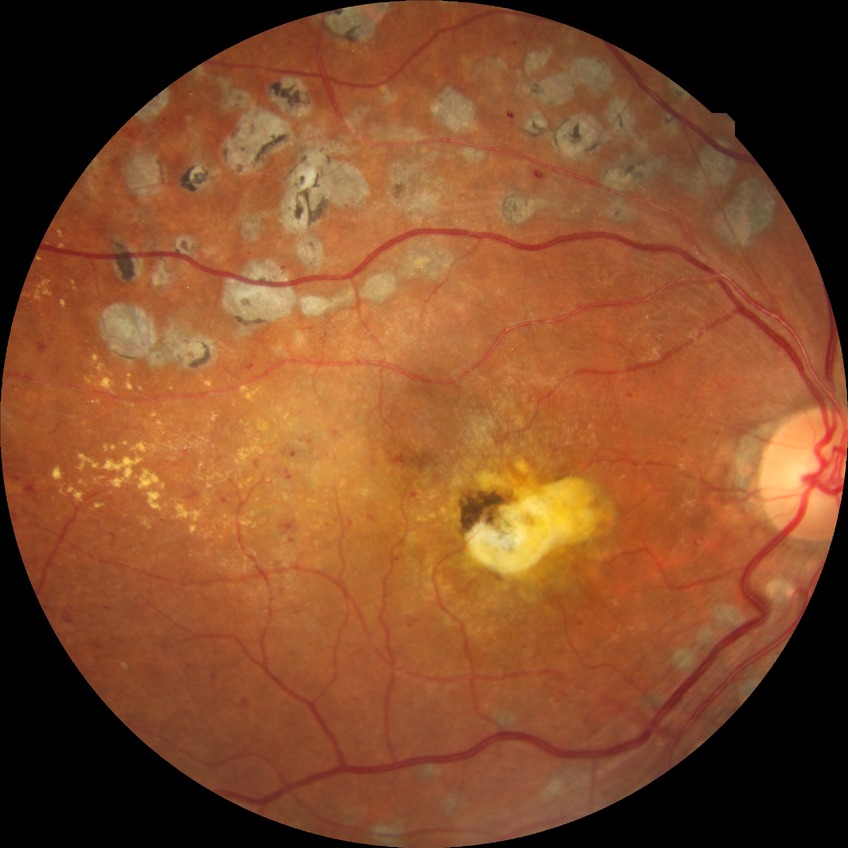
Assessment:
– retinopathy grade: proliferative diabetic retinopathy